45° FOV, image size 1932x1932:
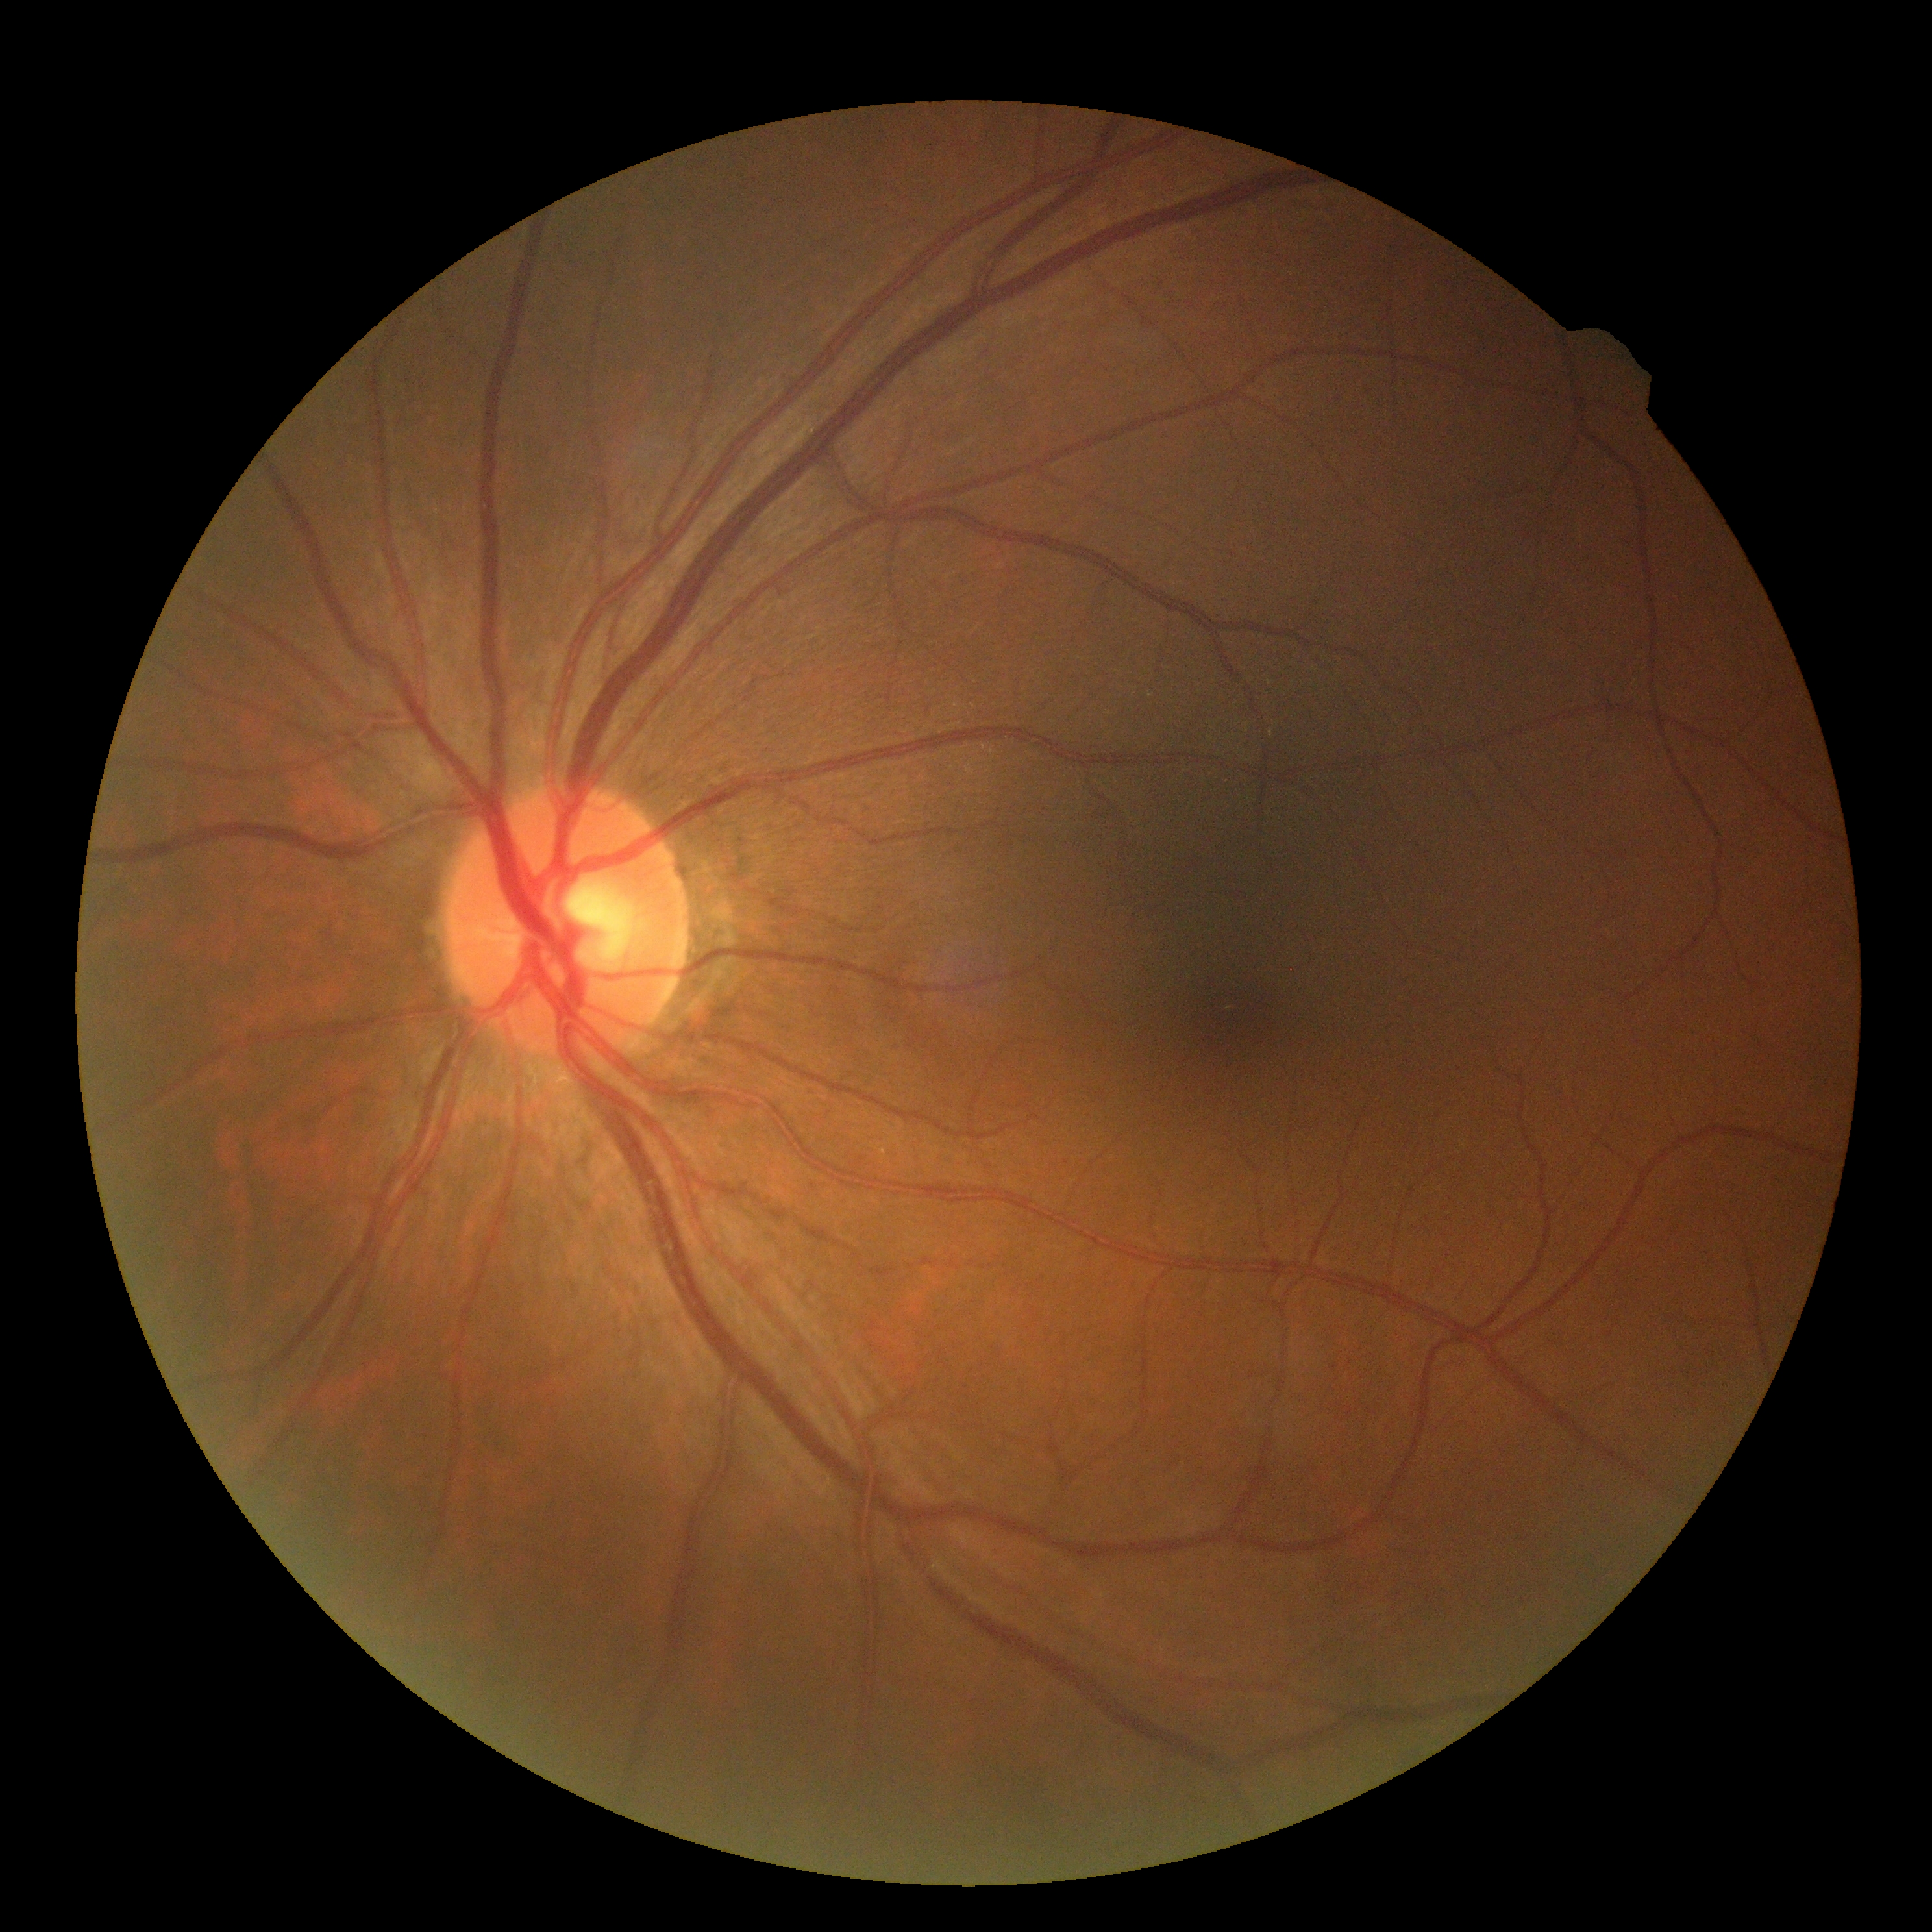

diabetic retinopathy severity = no apparent diabetic retinopathy (grade 0).